848 x 848 pixels, nonmydriatic, diabetic retinopathy graded by the modified Davis classification, fundus photo, camera: NIDEK AFC-230
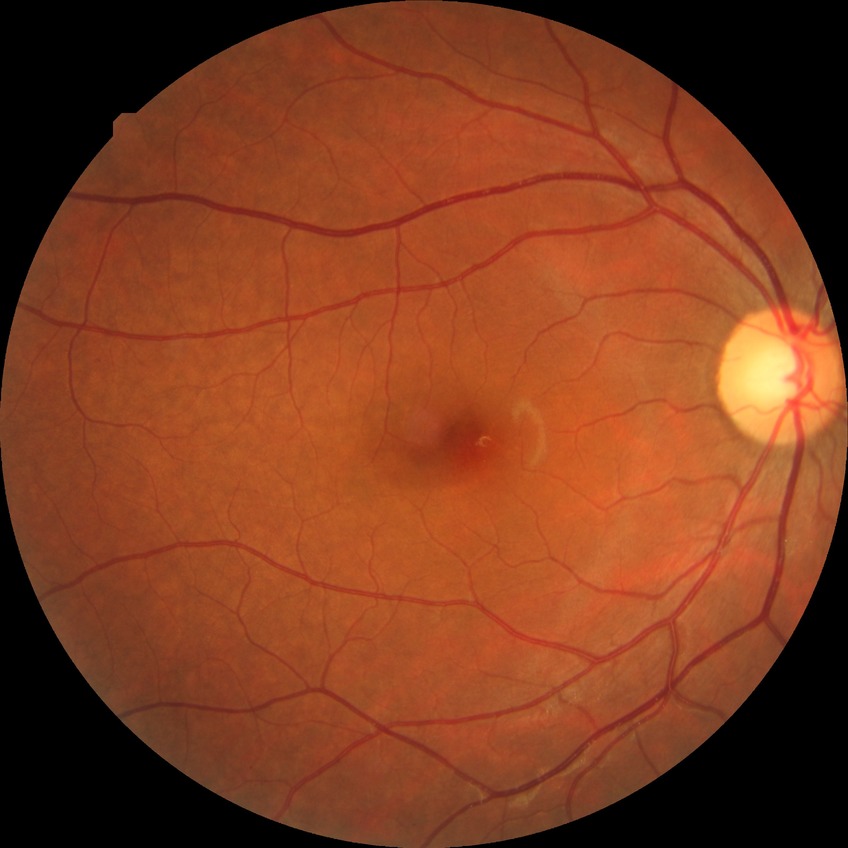

{"davis_grade": "no diabetic retinopathy"}